Acquired with a NIDEK AFC-230. Diabetic retinopathy graded by the modified Davis classification.
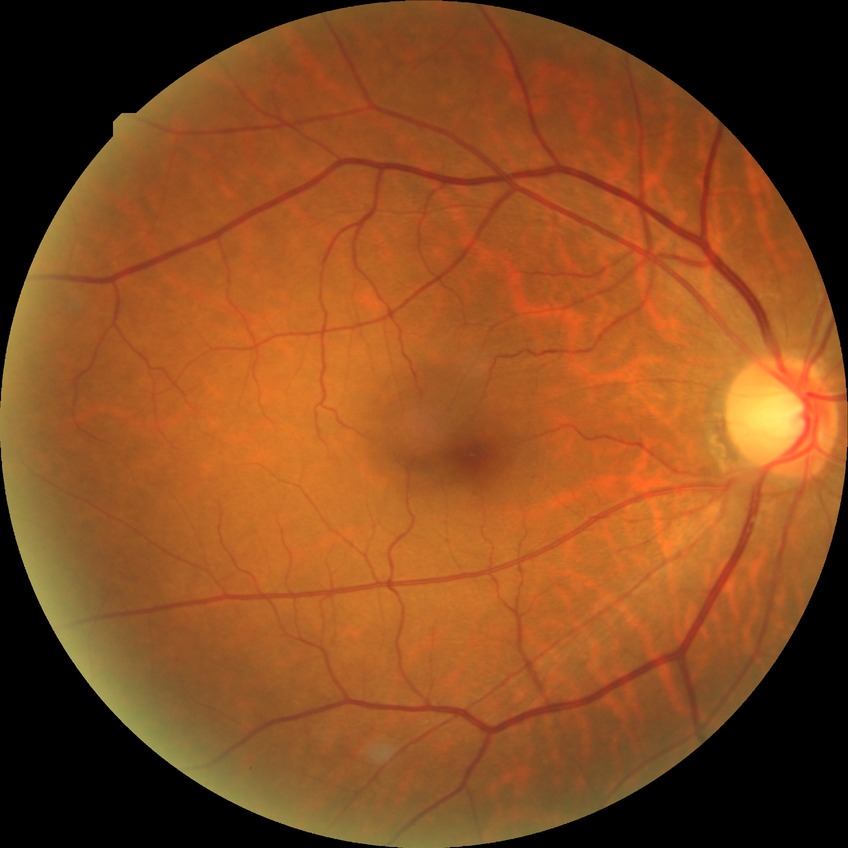

{"davis_grade": "SDR (simple diabetic retinopathy)"}